Color fundus image. 2352x1568px — 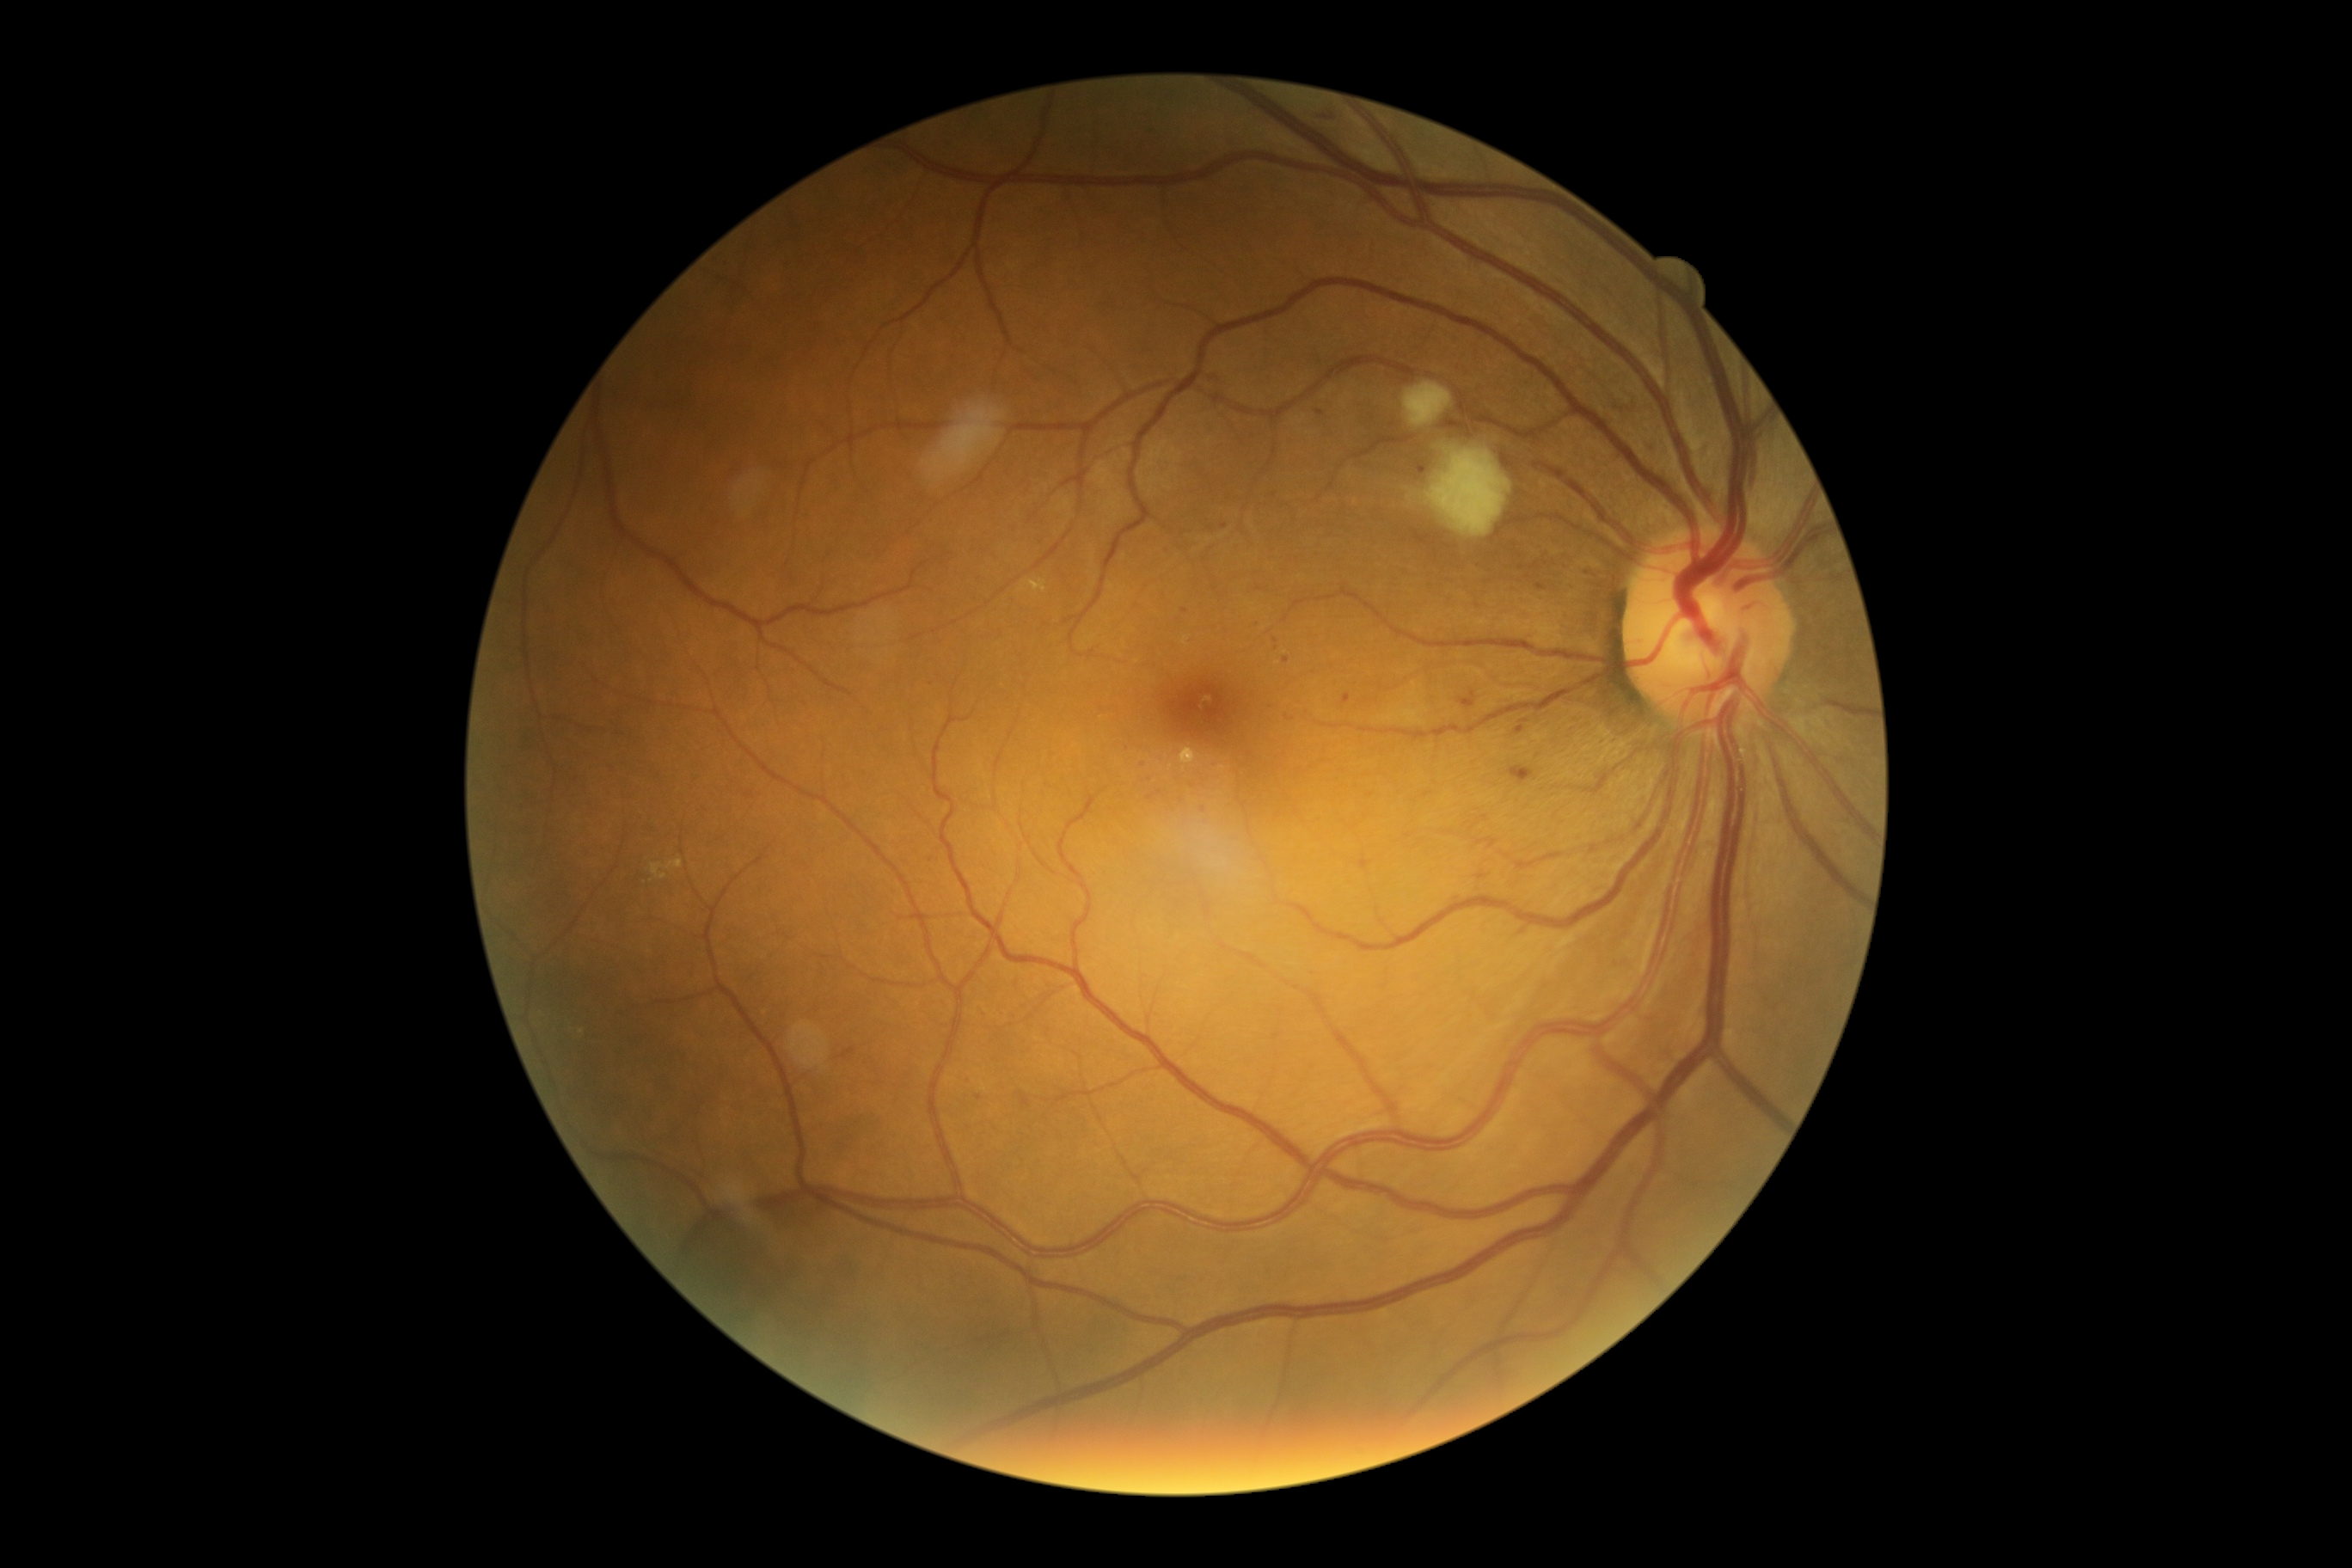
{
  "dr_category": "non-proliferative diabetic retinopathy",
  "dr_grade": "moderate NPDR (grade 2)"
}